Captured with the Phoenix ICON (100° field of view); wide-field fundus photograph of an infant
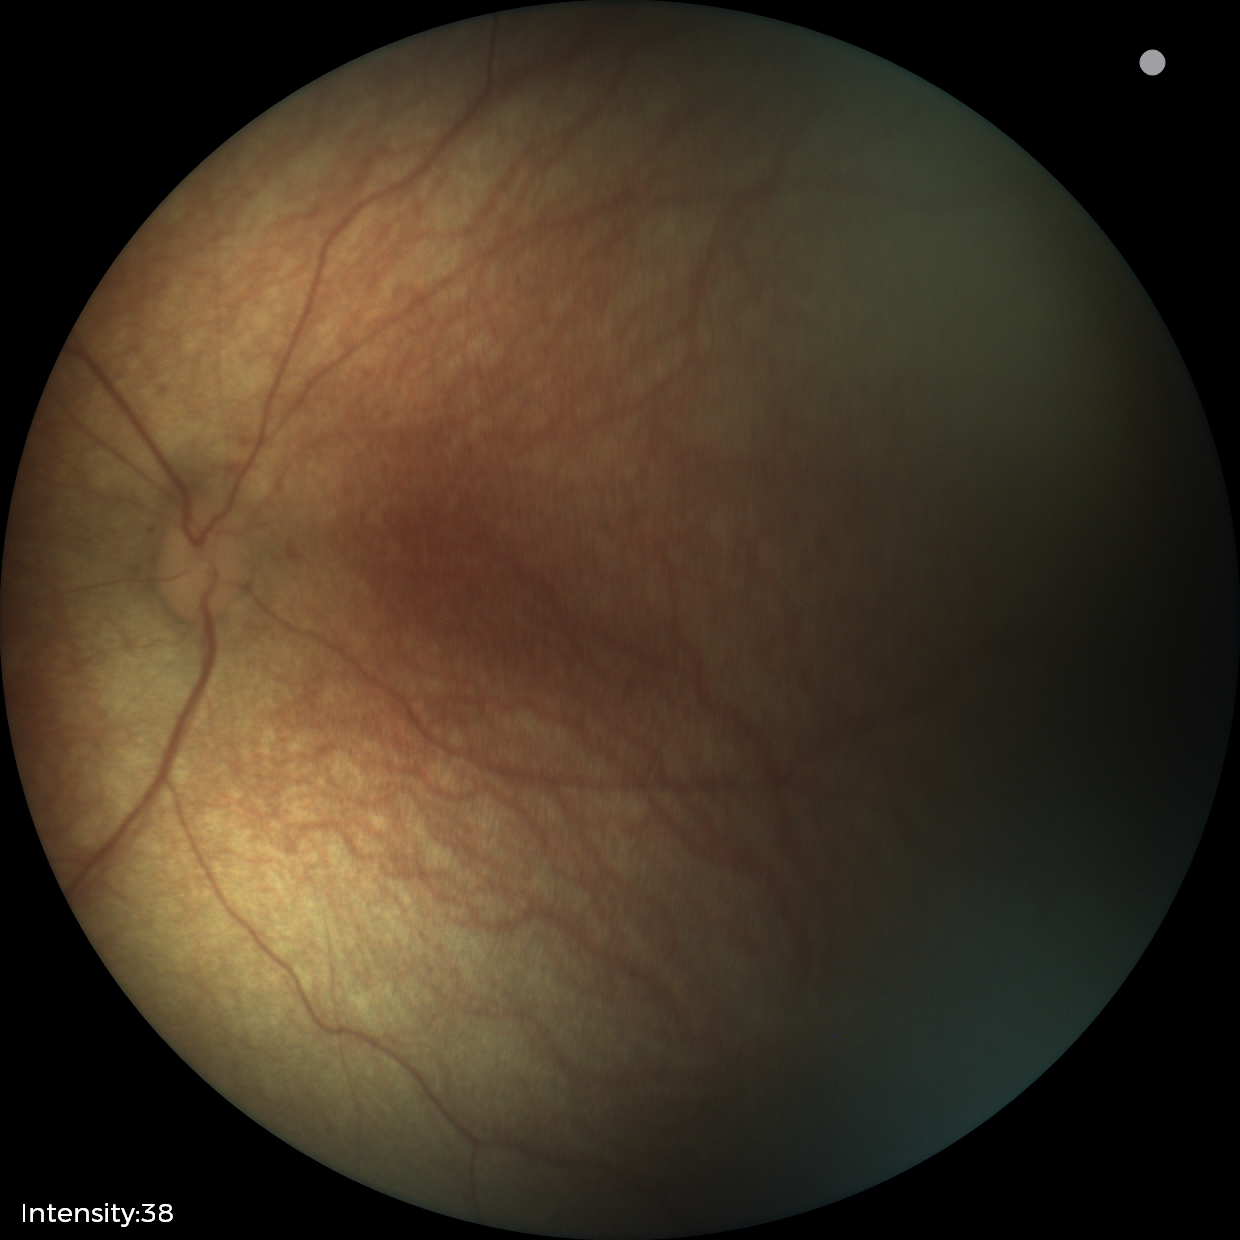
Impression: physiological appearance with no retinal pathology.